Diabetic retinopathy graded by the modified Davis classification; 848 by 848 pixels
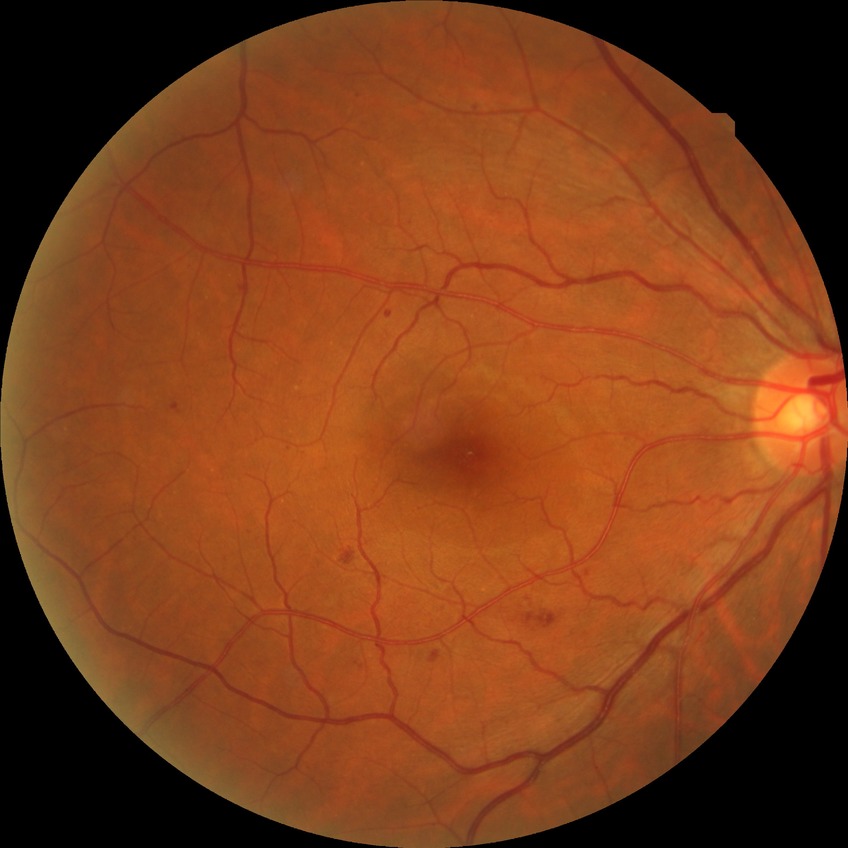

Modified Davis classification is simple diabetic retinopathy.